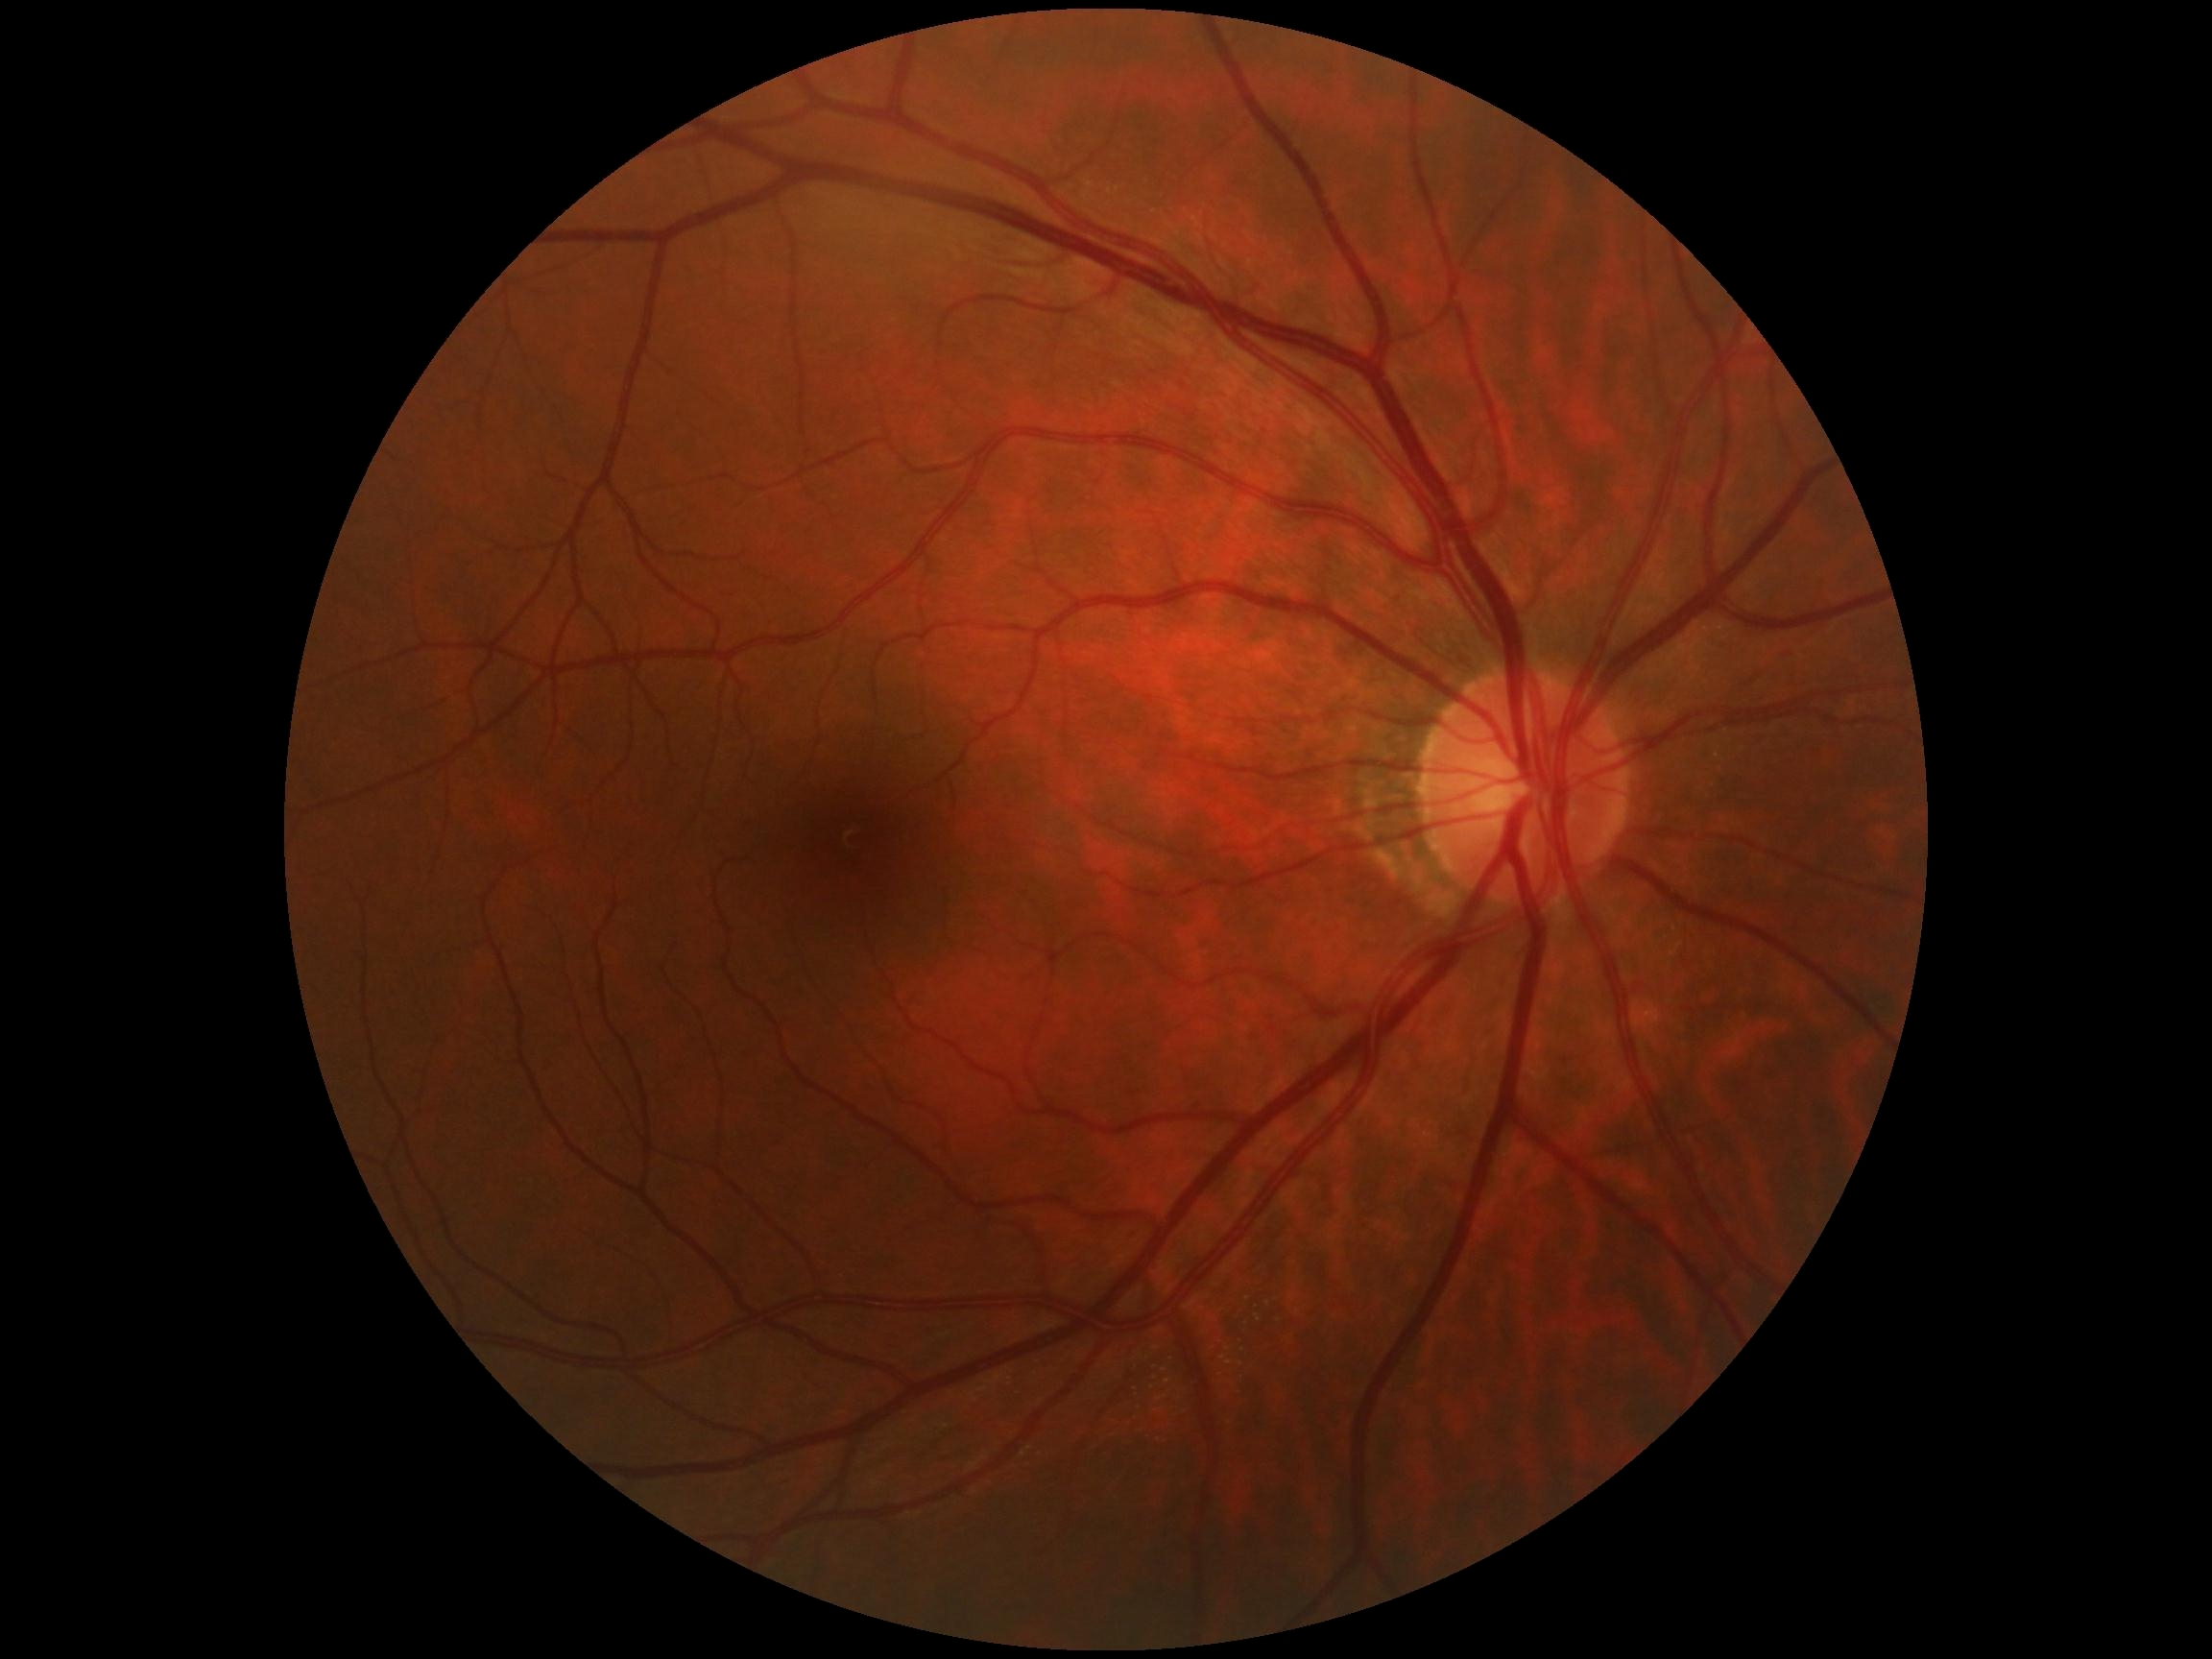 DR severity is no apparent retinopathy (grade 0).